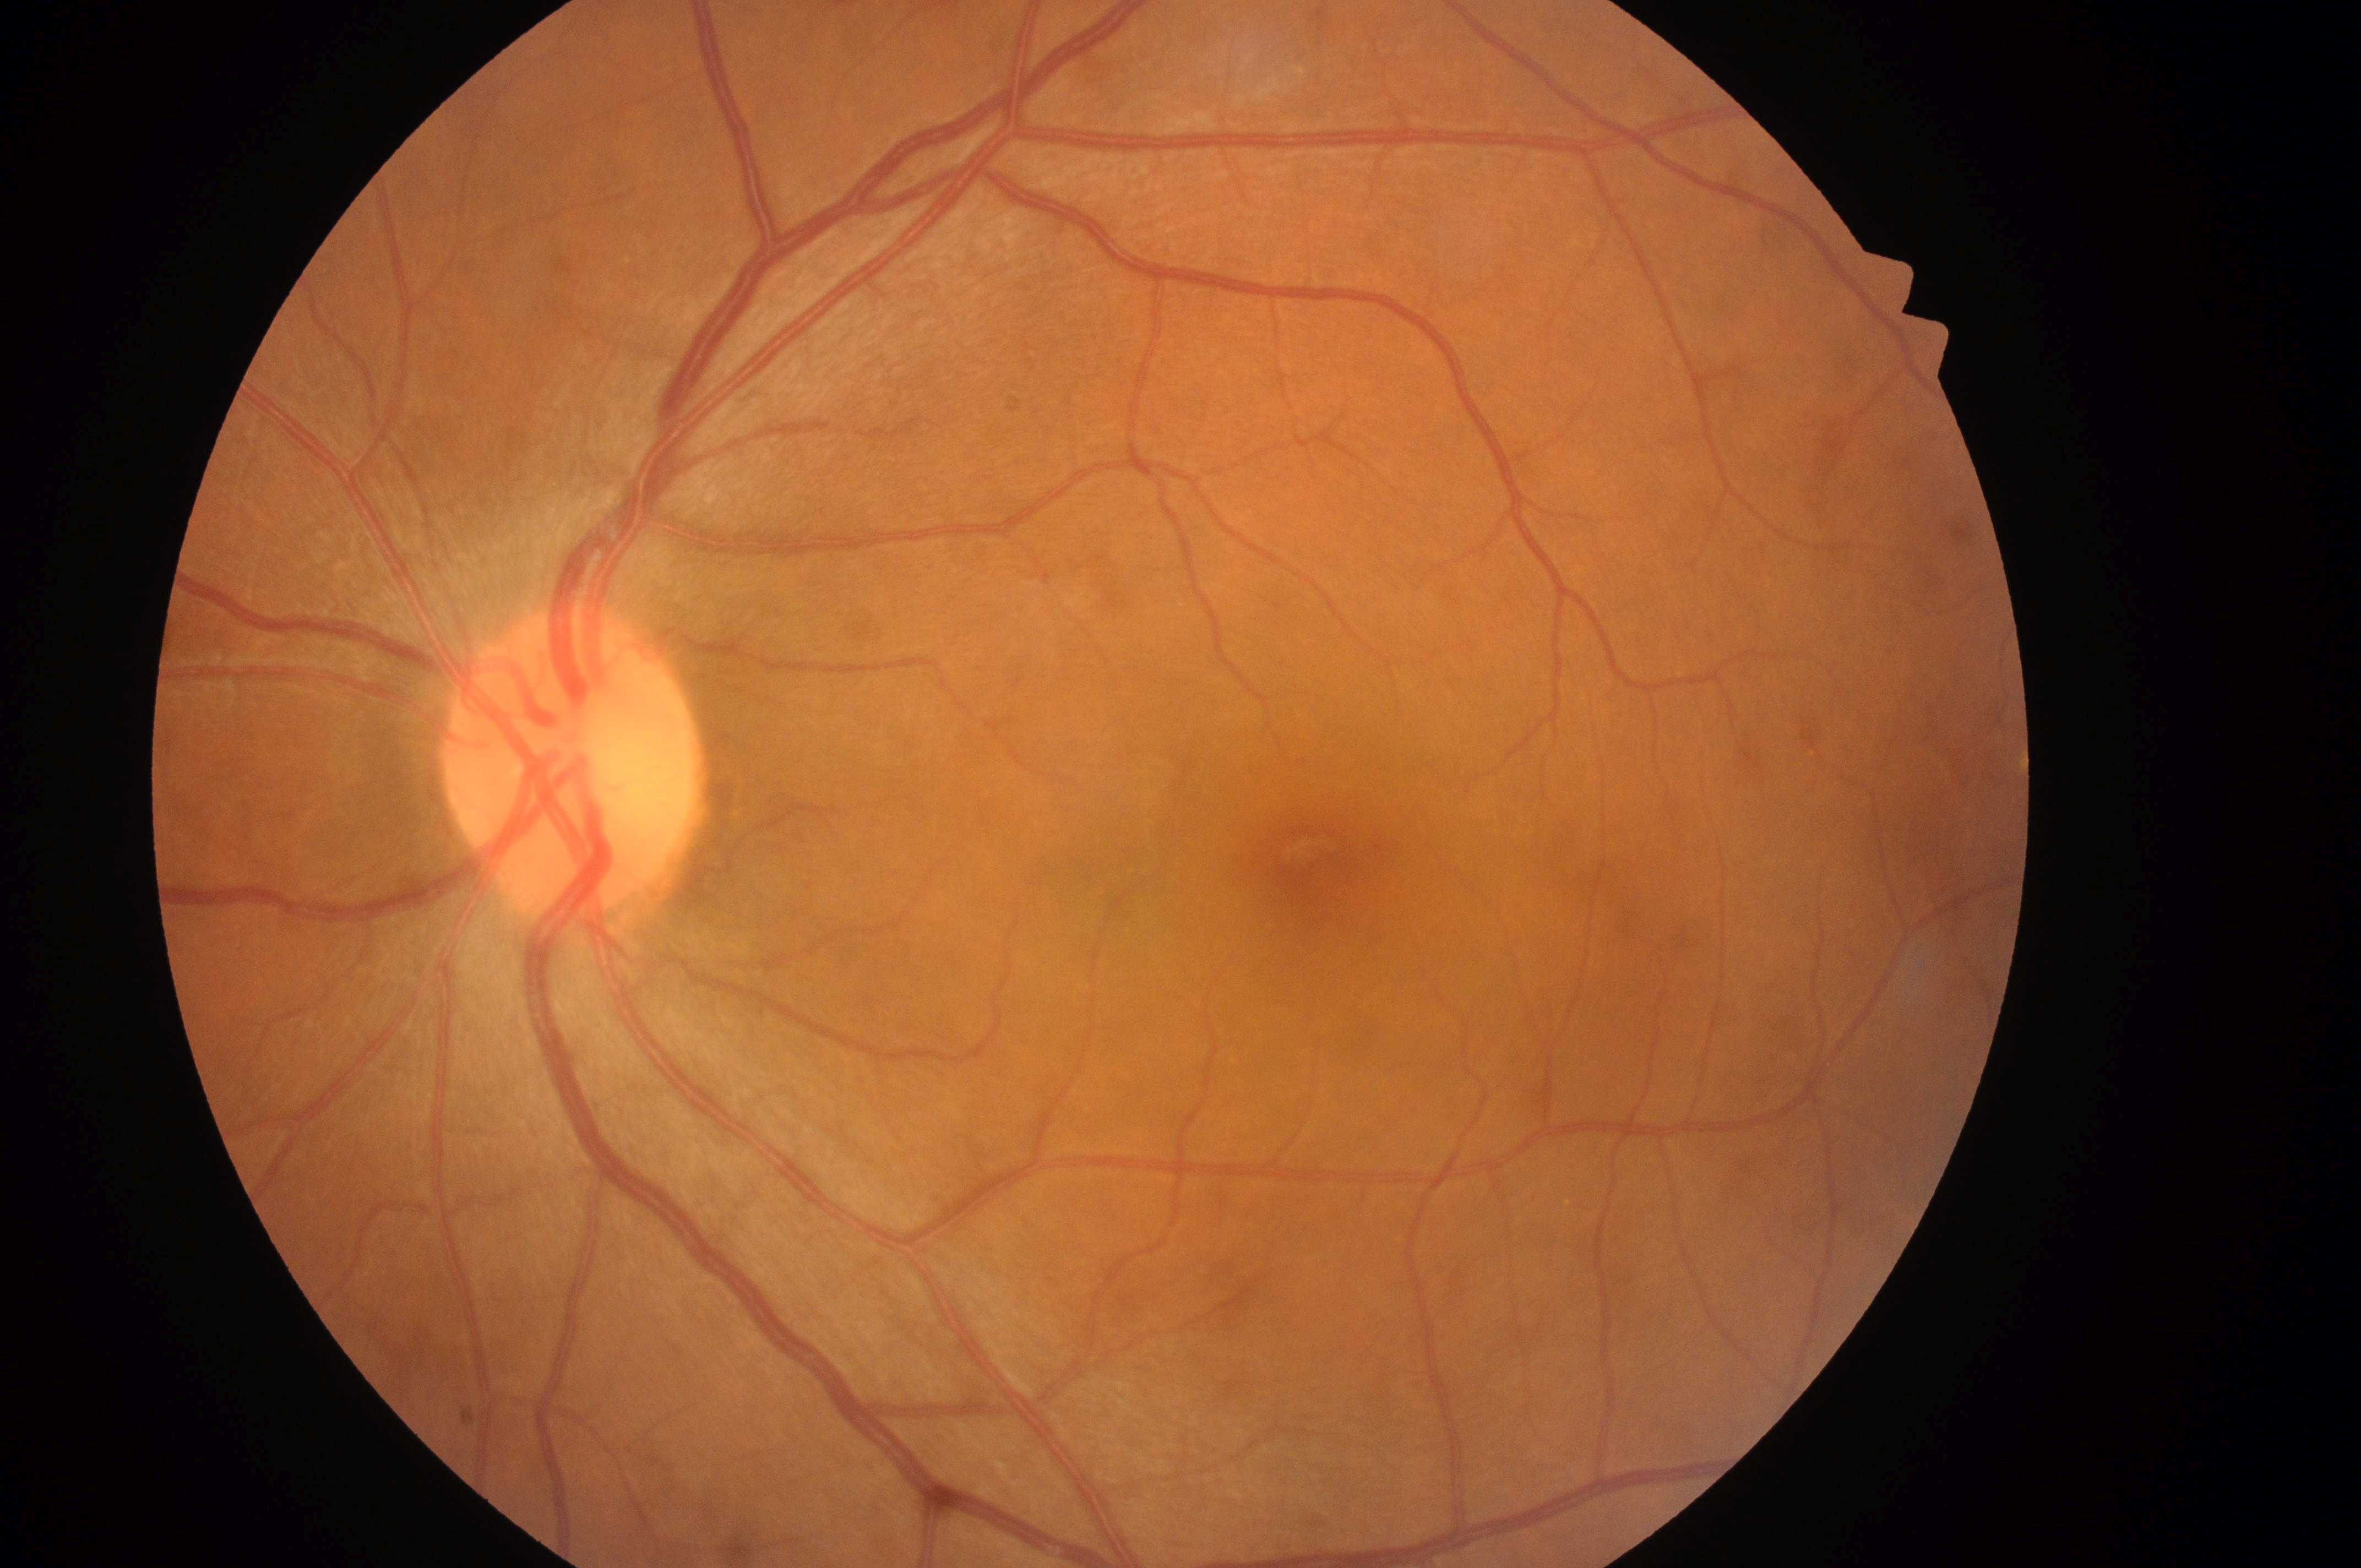

Imaged eye: the left eye. Optic disc: [567, 777]. Diabetic macular edema: 0/2. The macula center is at [1320, 868]. Diabetic retinopathy grade: 0.